Pupil-dilated — 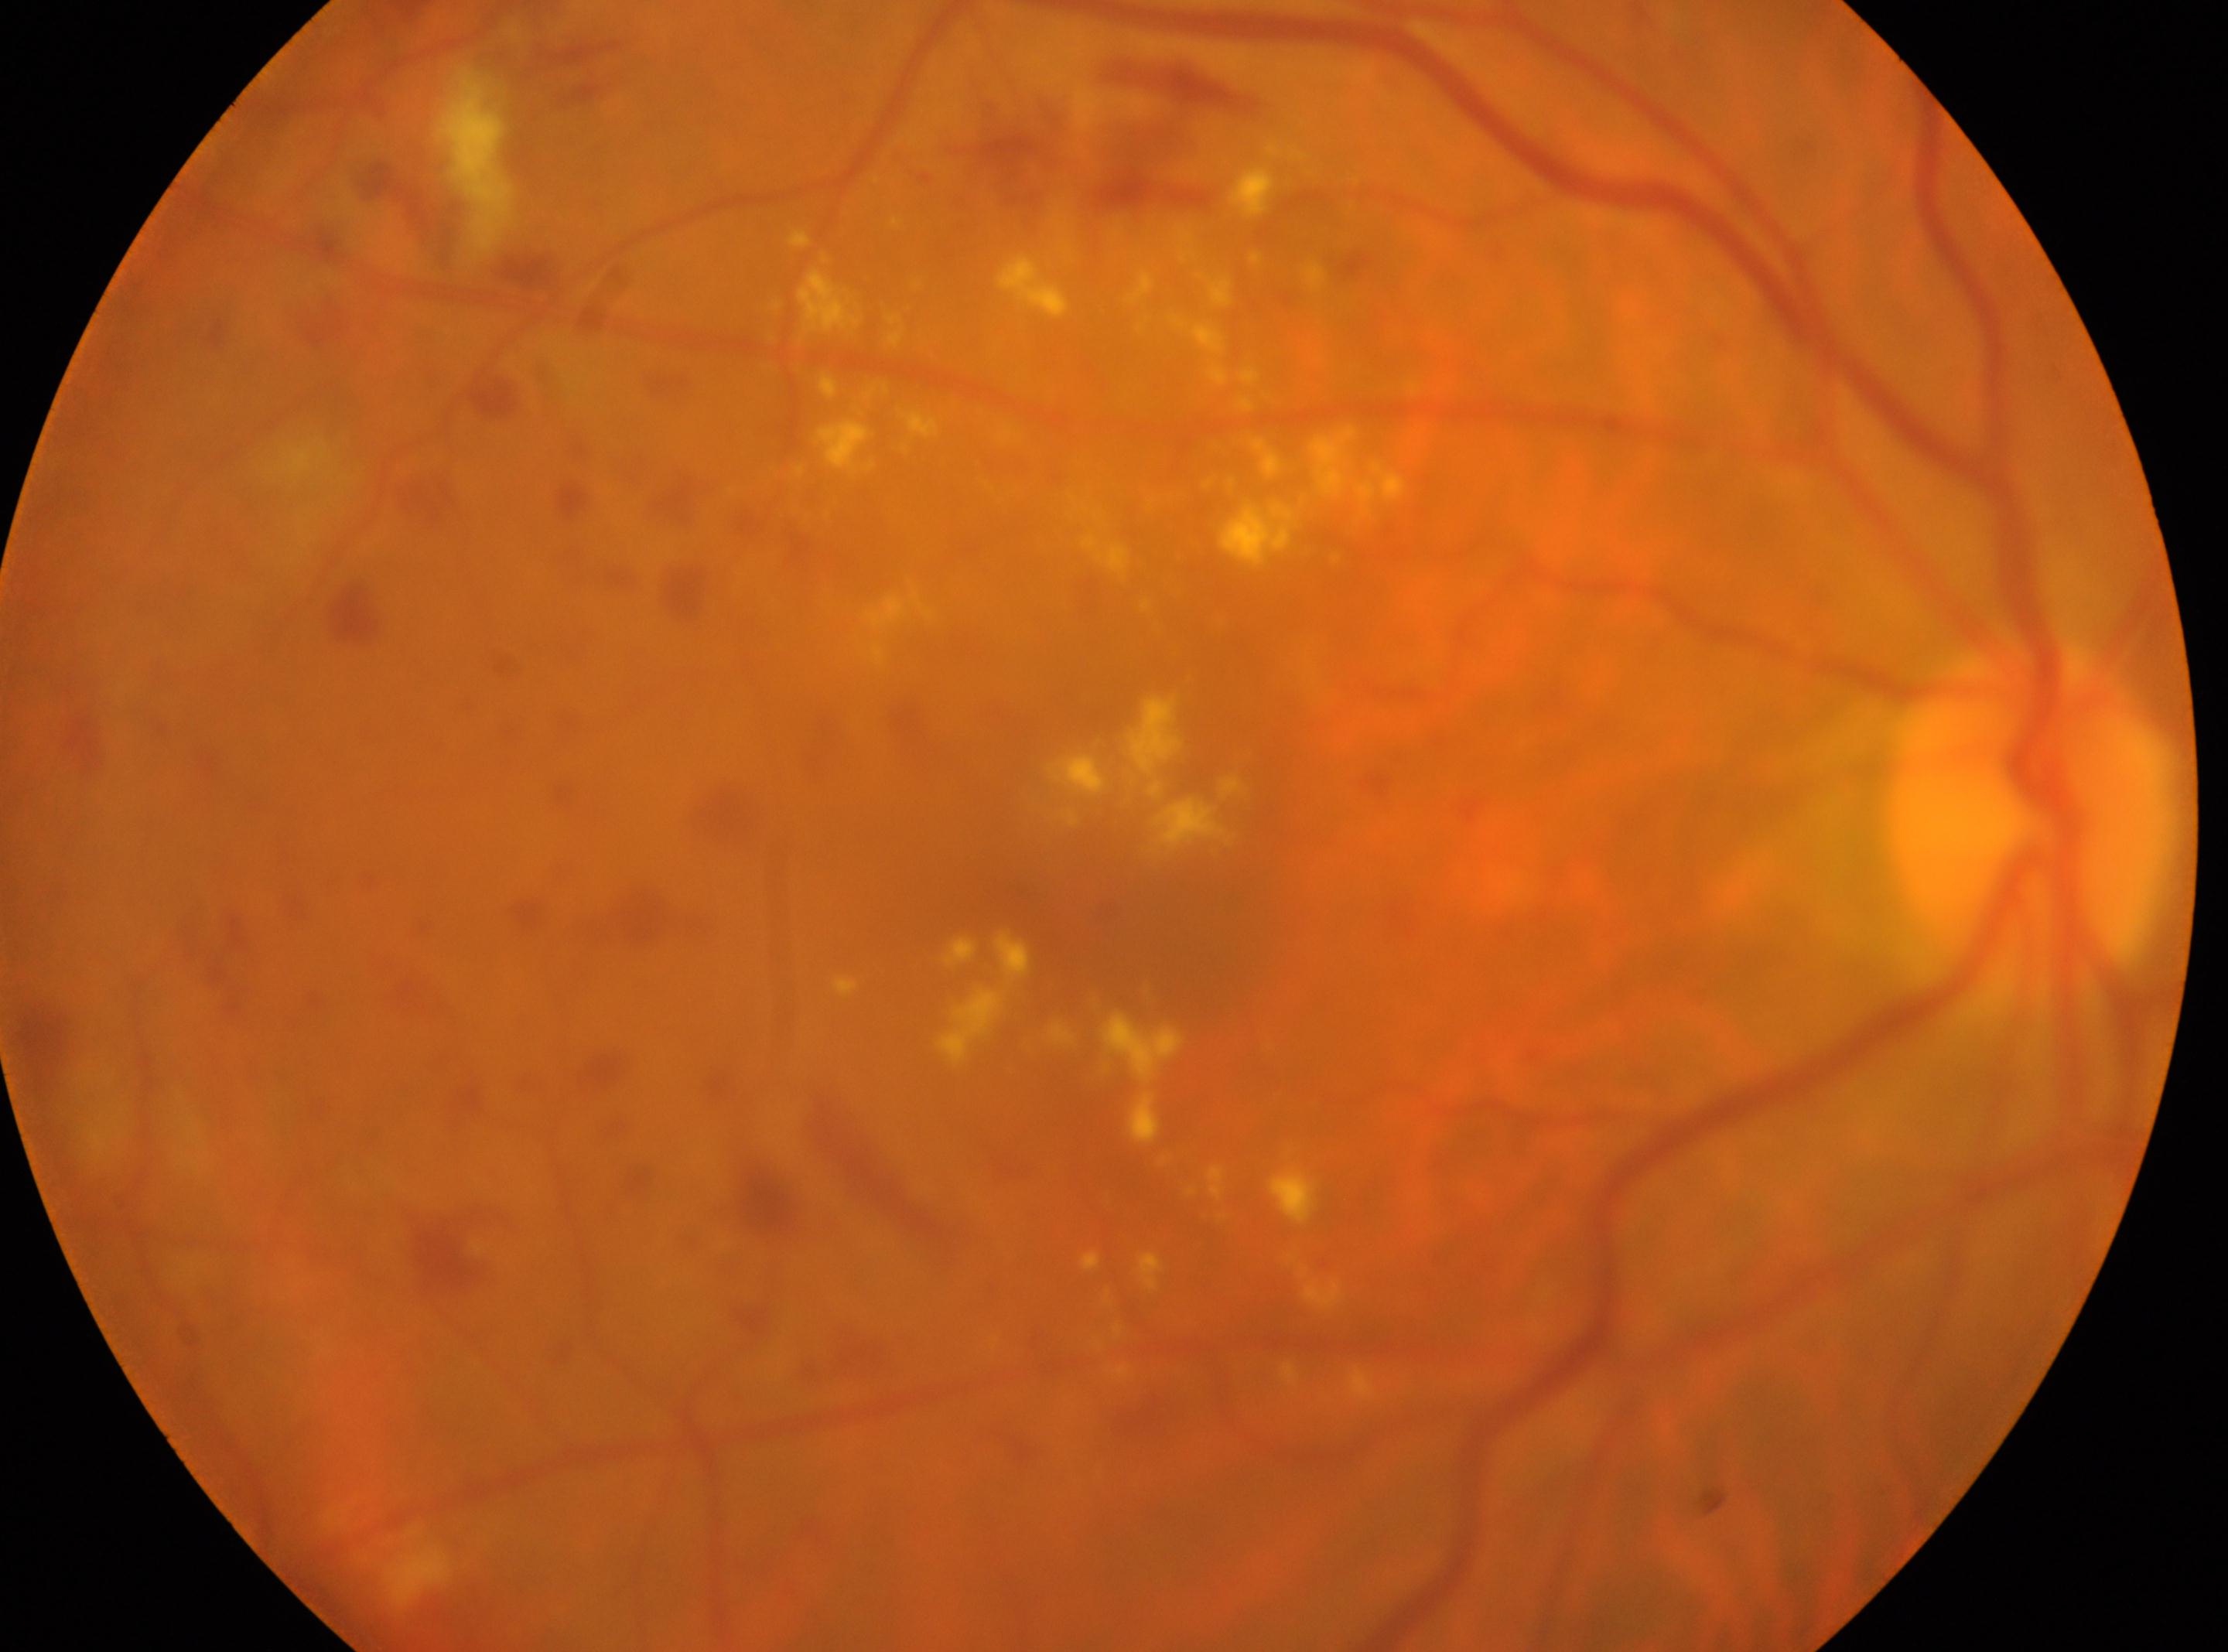
  eye: the right eye
  optic_disc: [2030, 817]
  dr_grade: 2 (moderate NPDR)
  fovea: [1170, 954]
  dr_category: non-proliferative diabetic retinopathy